2352x1568px; CFP: 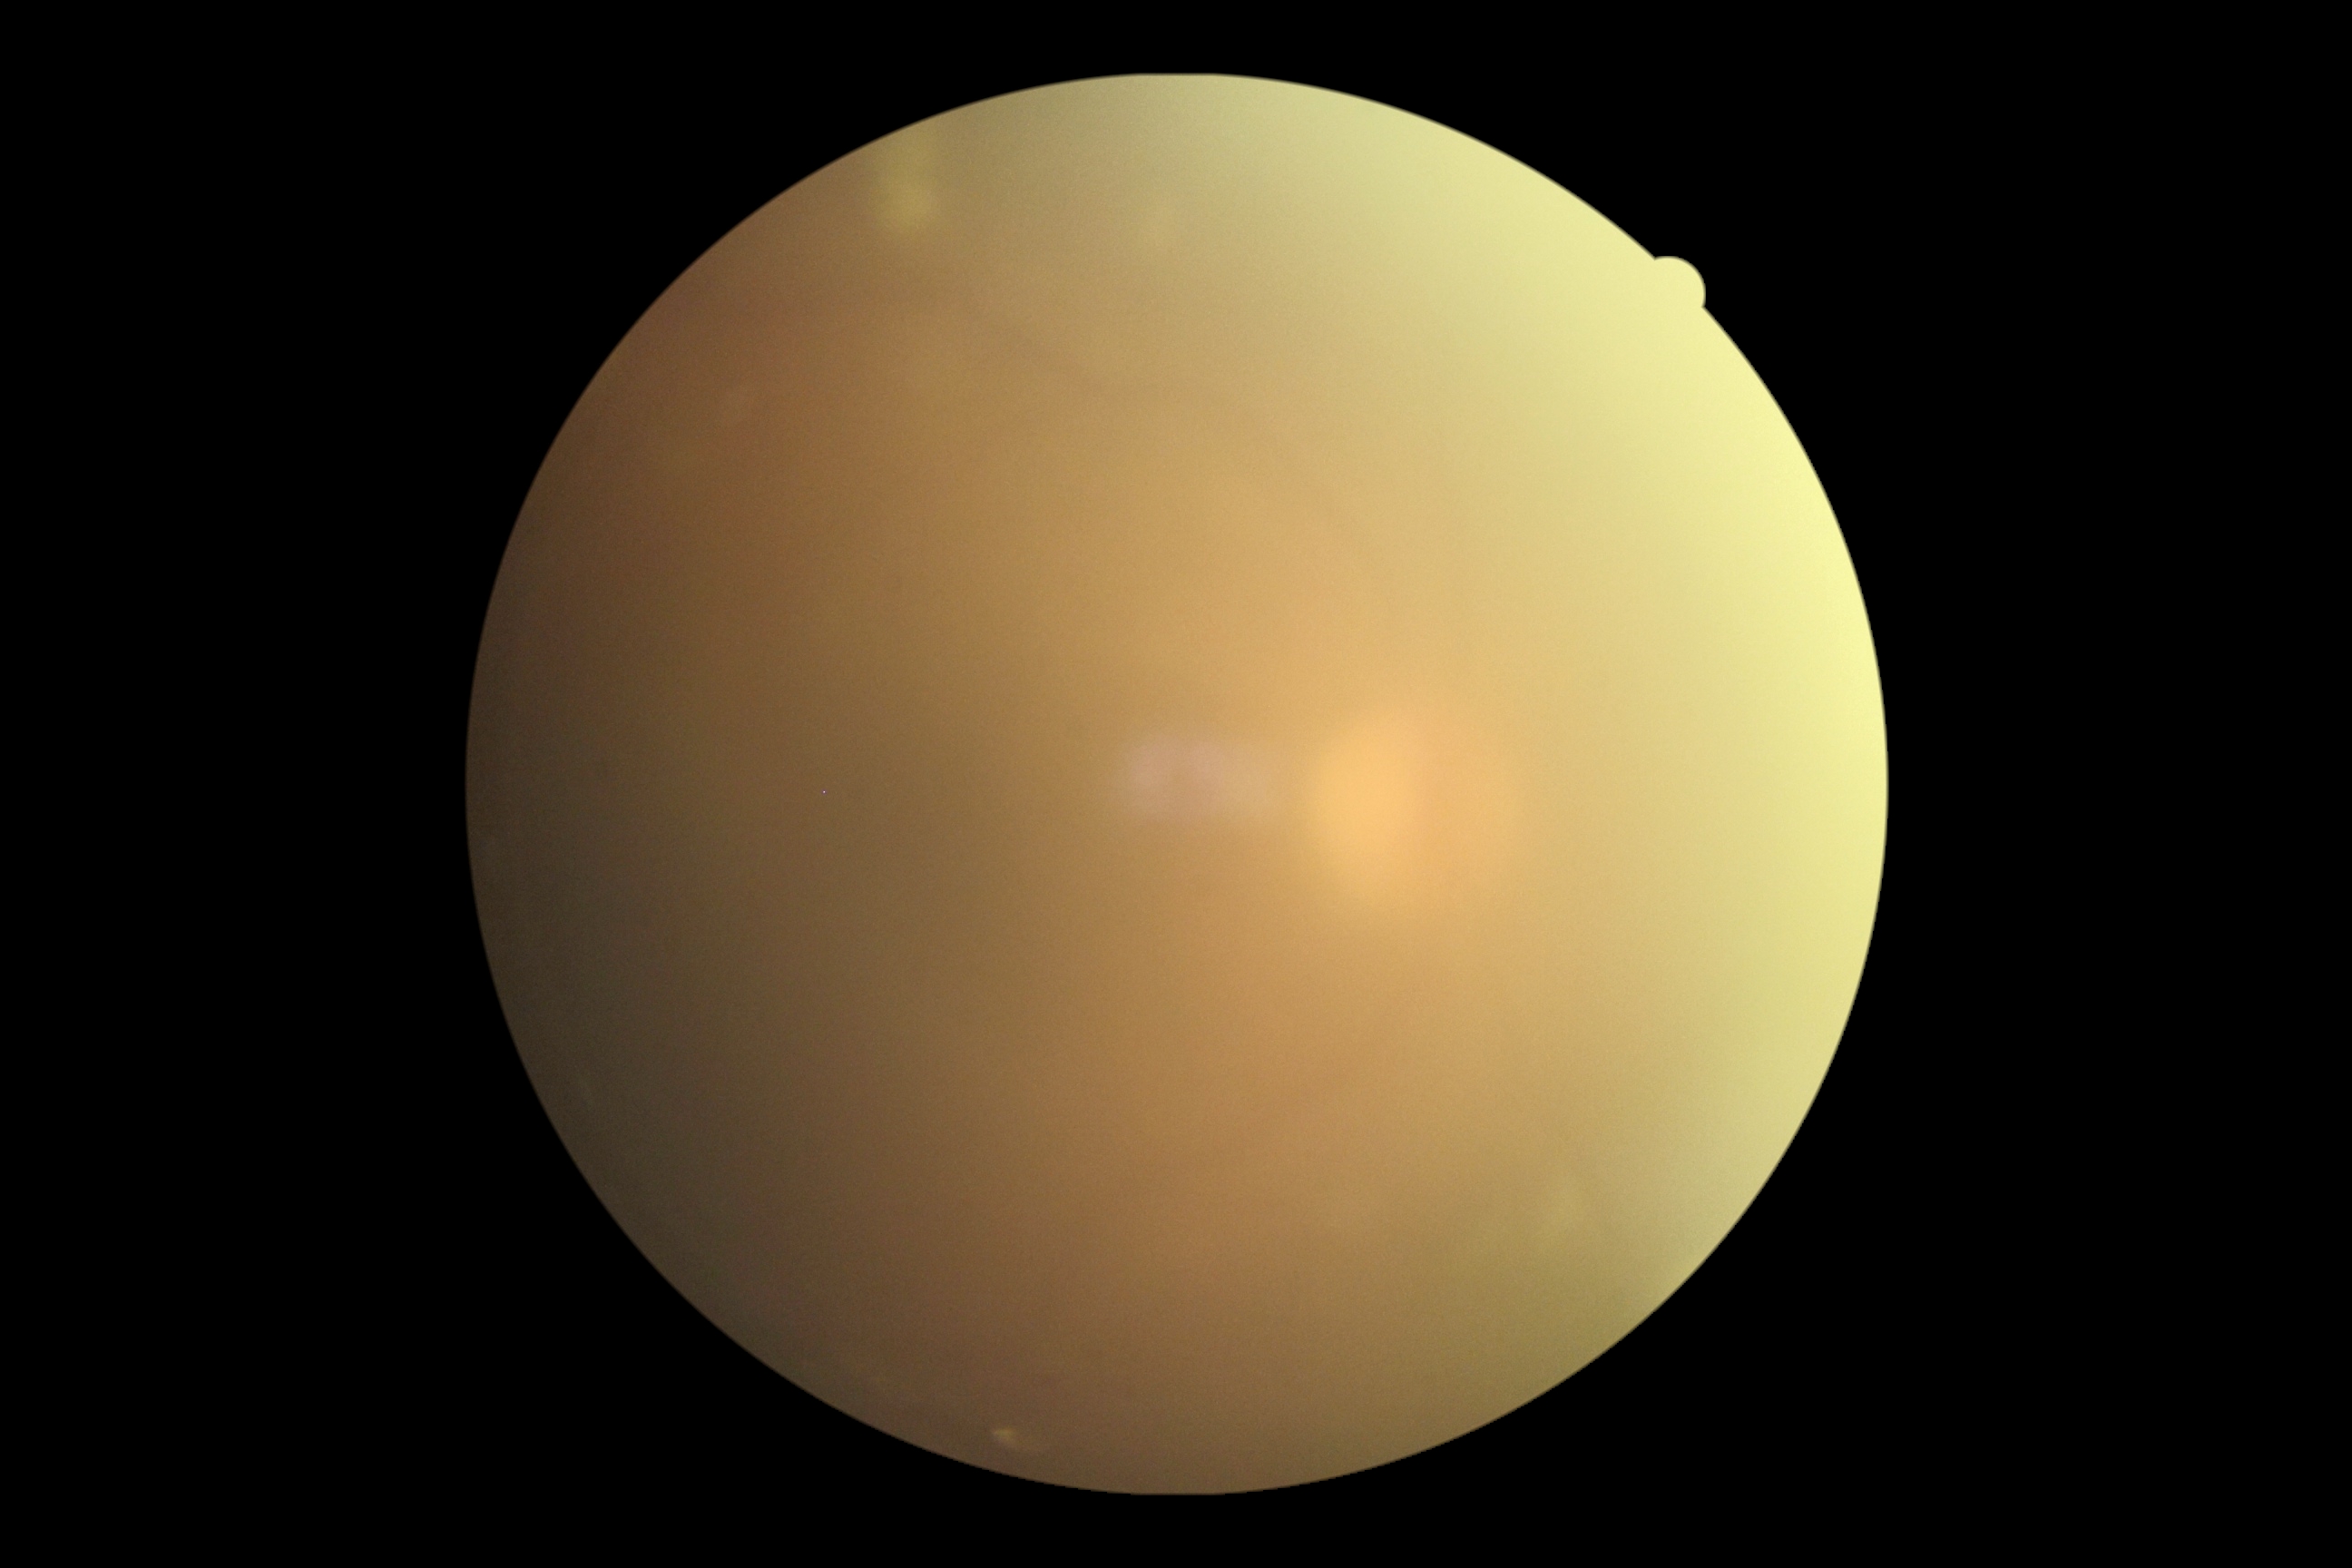 DR: ungradable